45° FOV · NIDEK AFC-230 · 848x848 · posterior pole photograph · without pupil dilation.
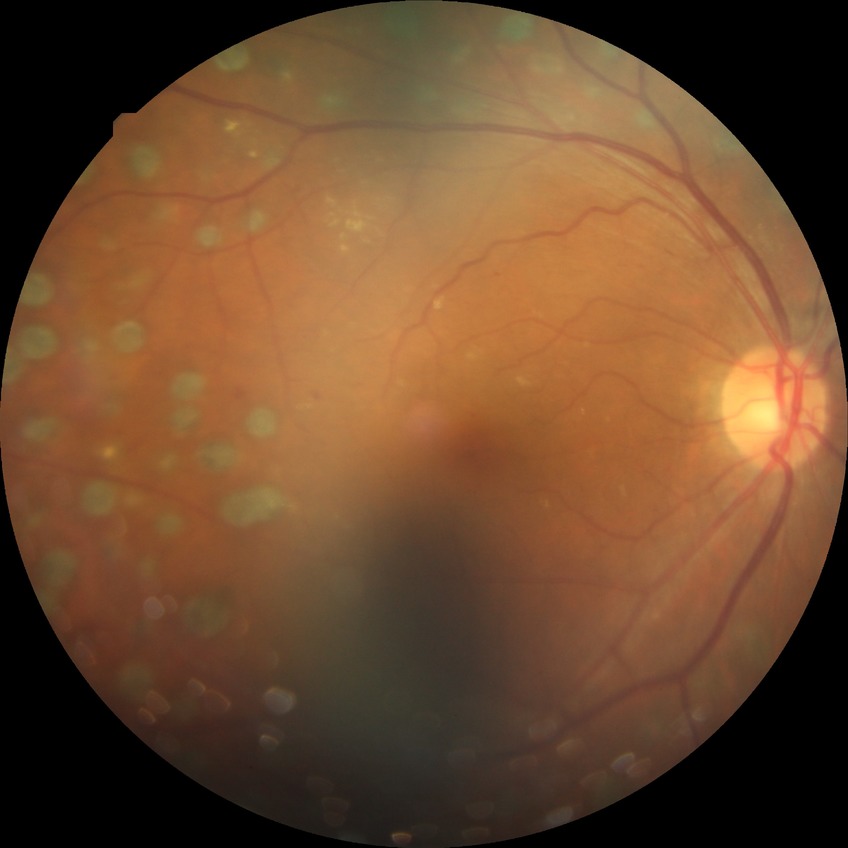

Annotations:
• diabetic retinopathy (DR): proliferative diabetic retinopathy (PDR)